640x480. 130° field of view (Clarity RetCam 3). Infant wide-field fundus photograph — 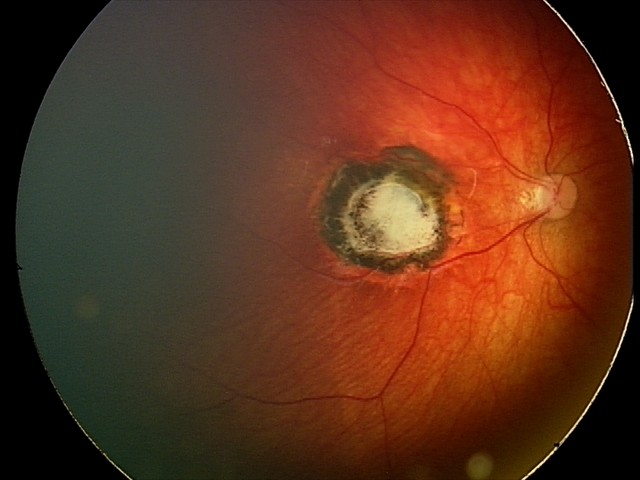
From an examination with diagnosis of toxoplasmosis chorioretinitis.